NIDEK AFC-230 — 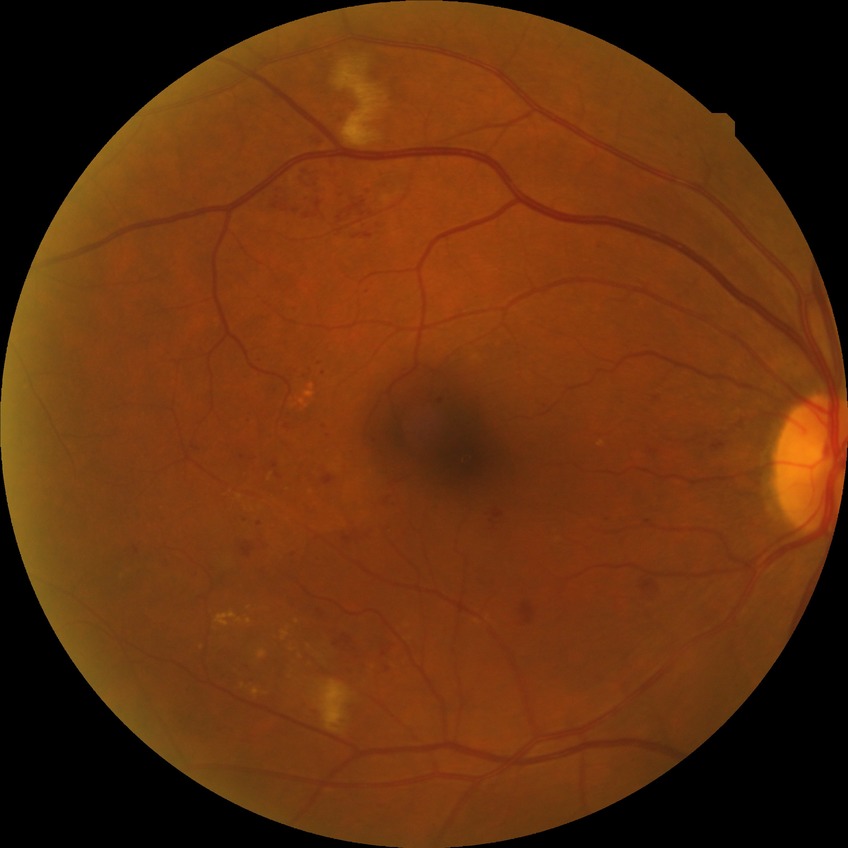
Diabetic retinopathy (DR): SDR (simple diabetic retinopathy).
Disease class: non-proliferative diabetic retinopathy.